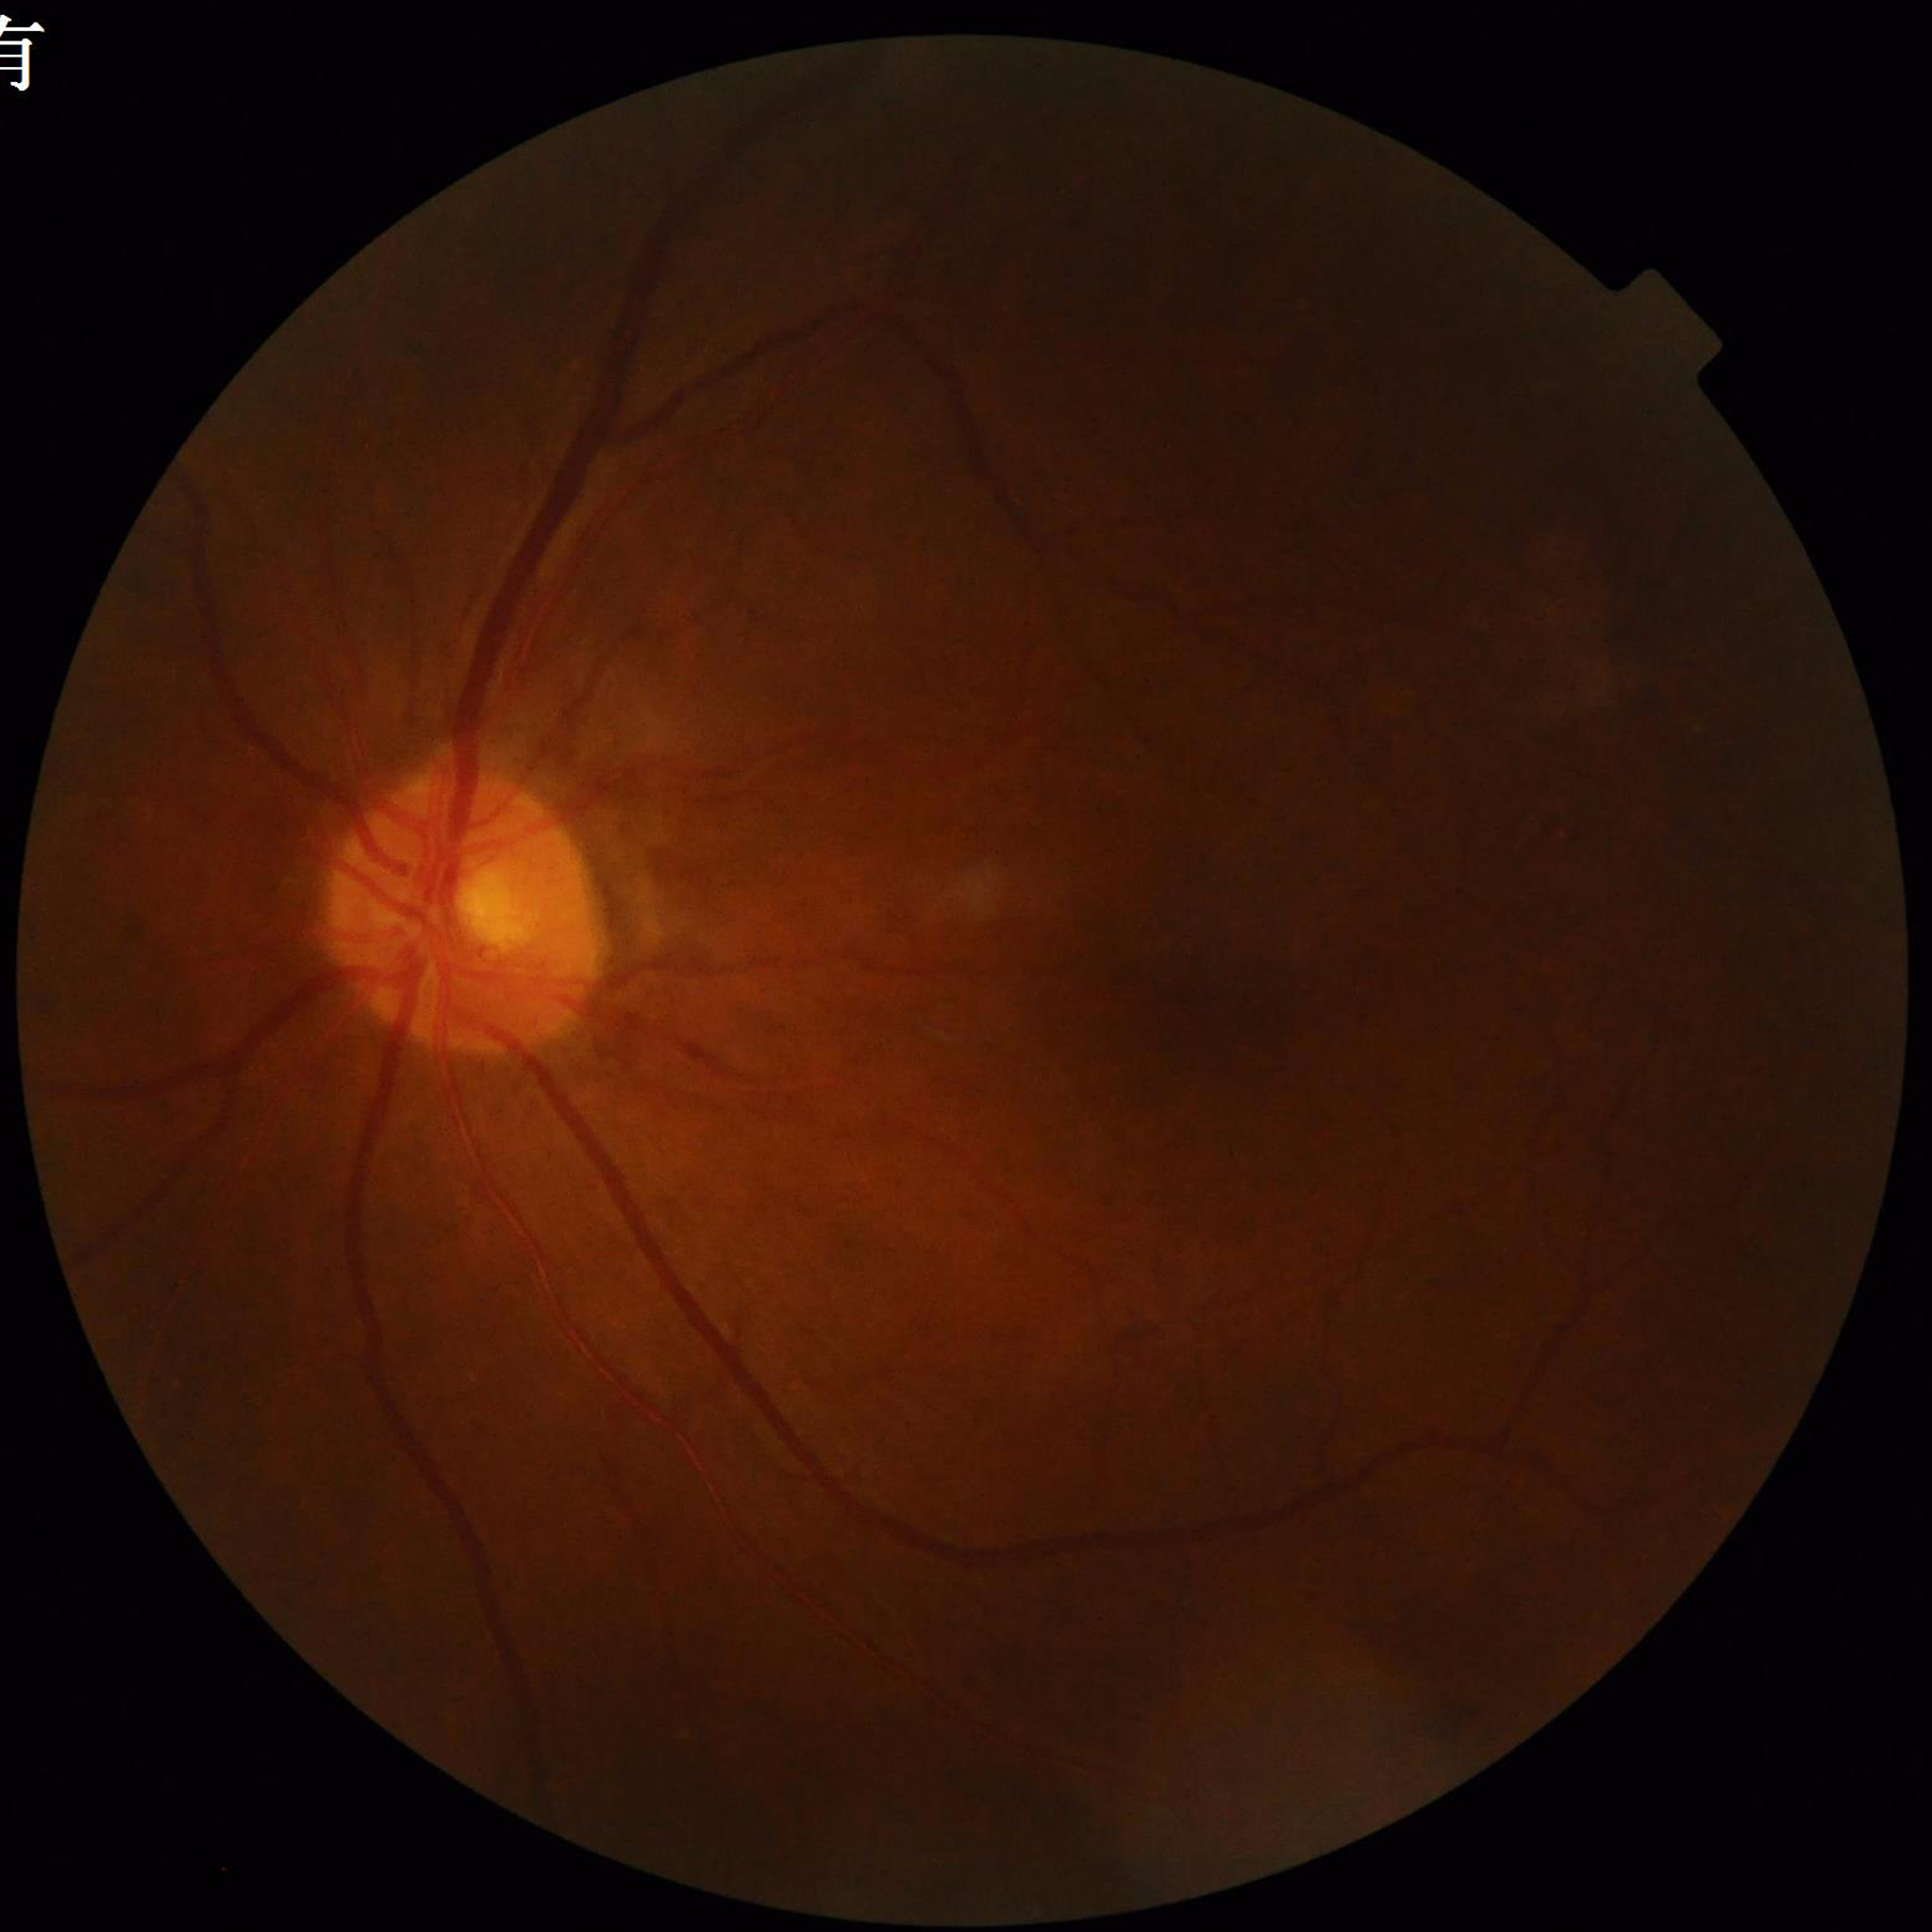

Quality: suboptimal — blur, illumination/color distortion; Clinical diagnosis: diabetic retinopathy.